FOV: 45 degrees:
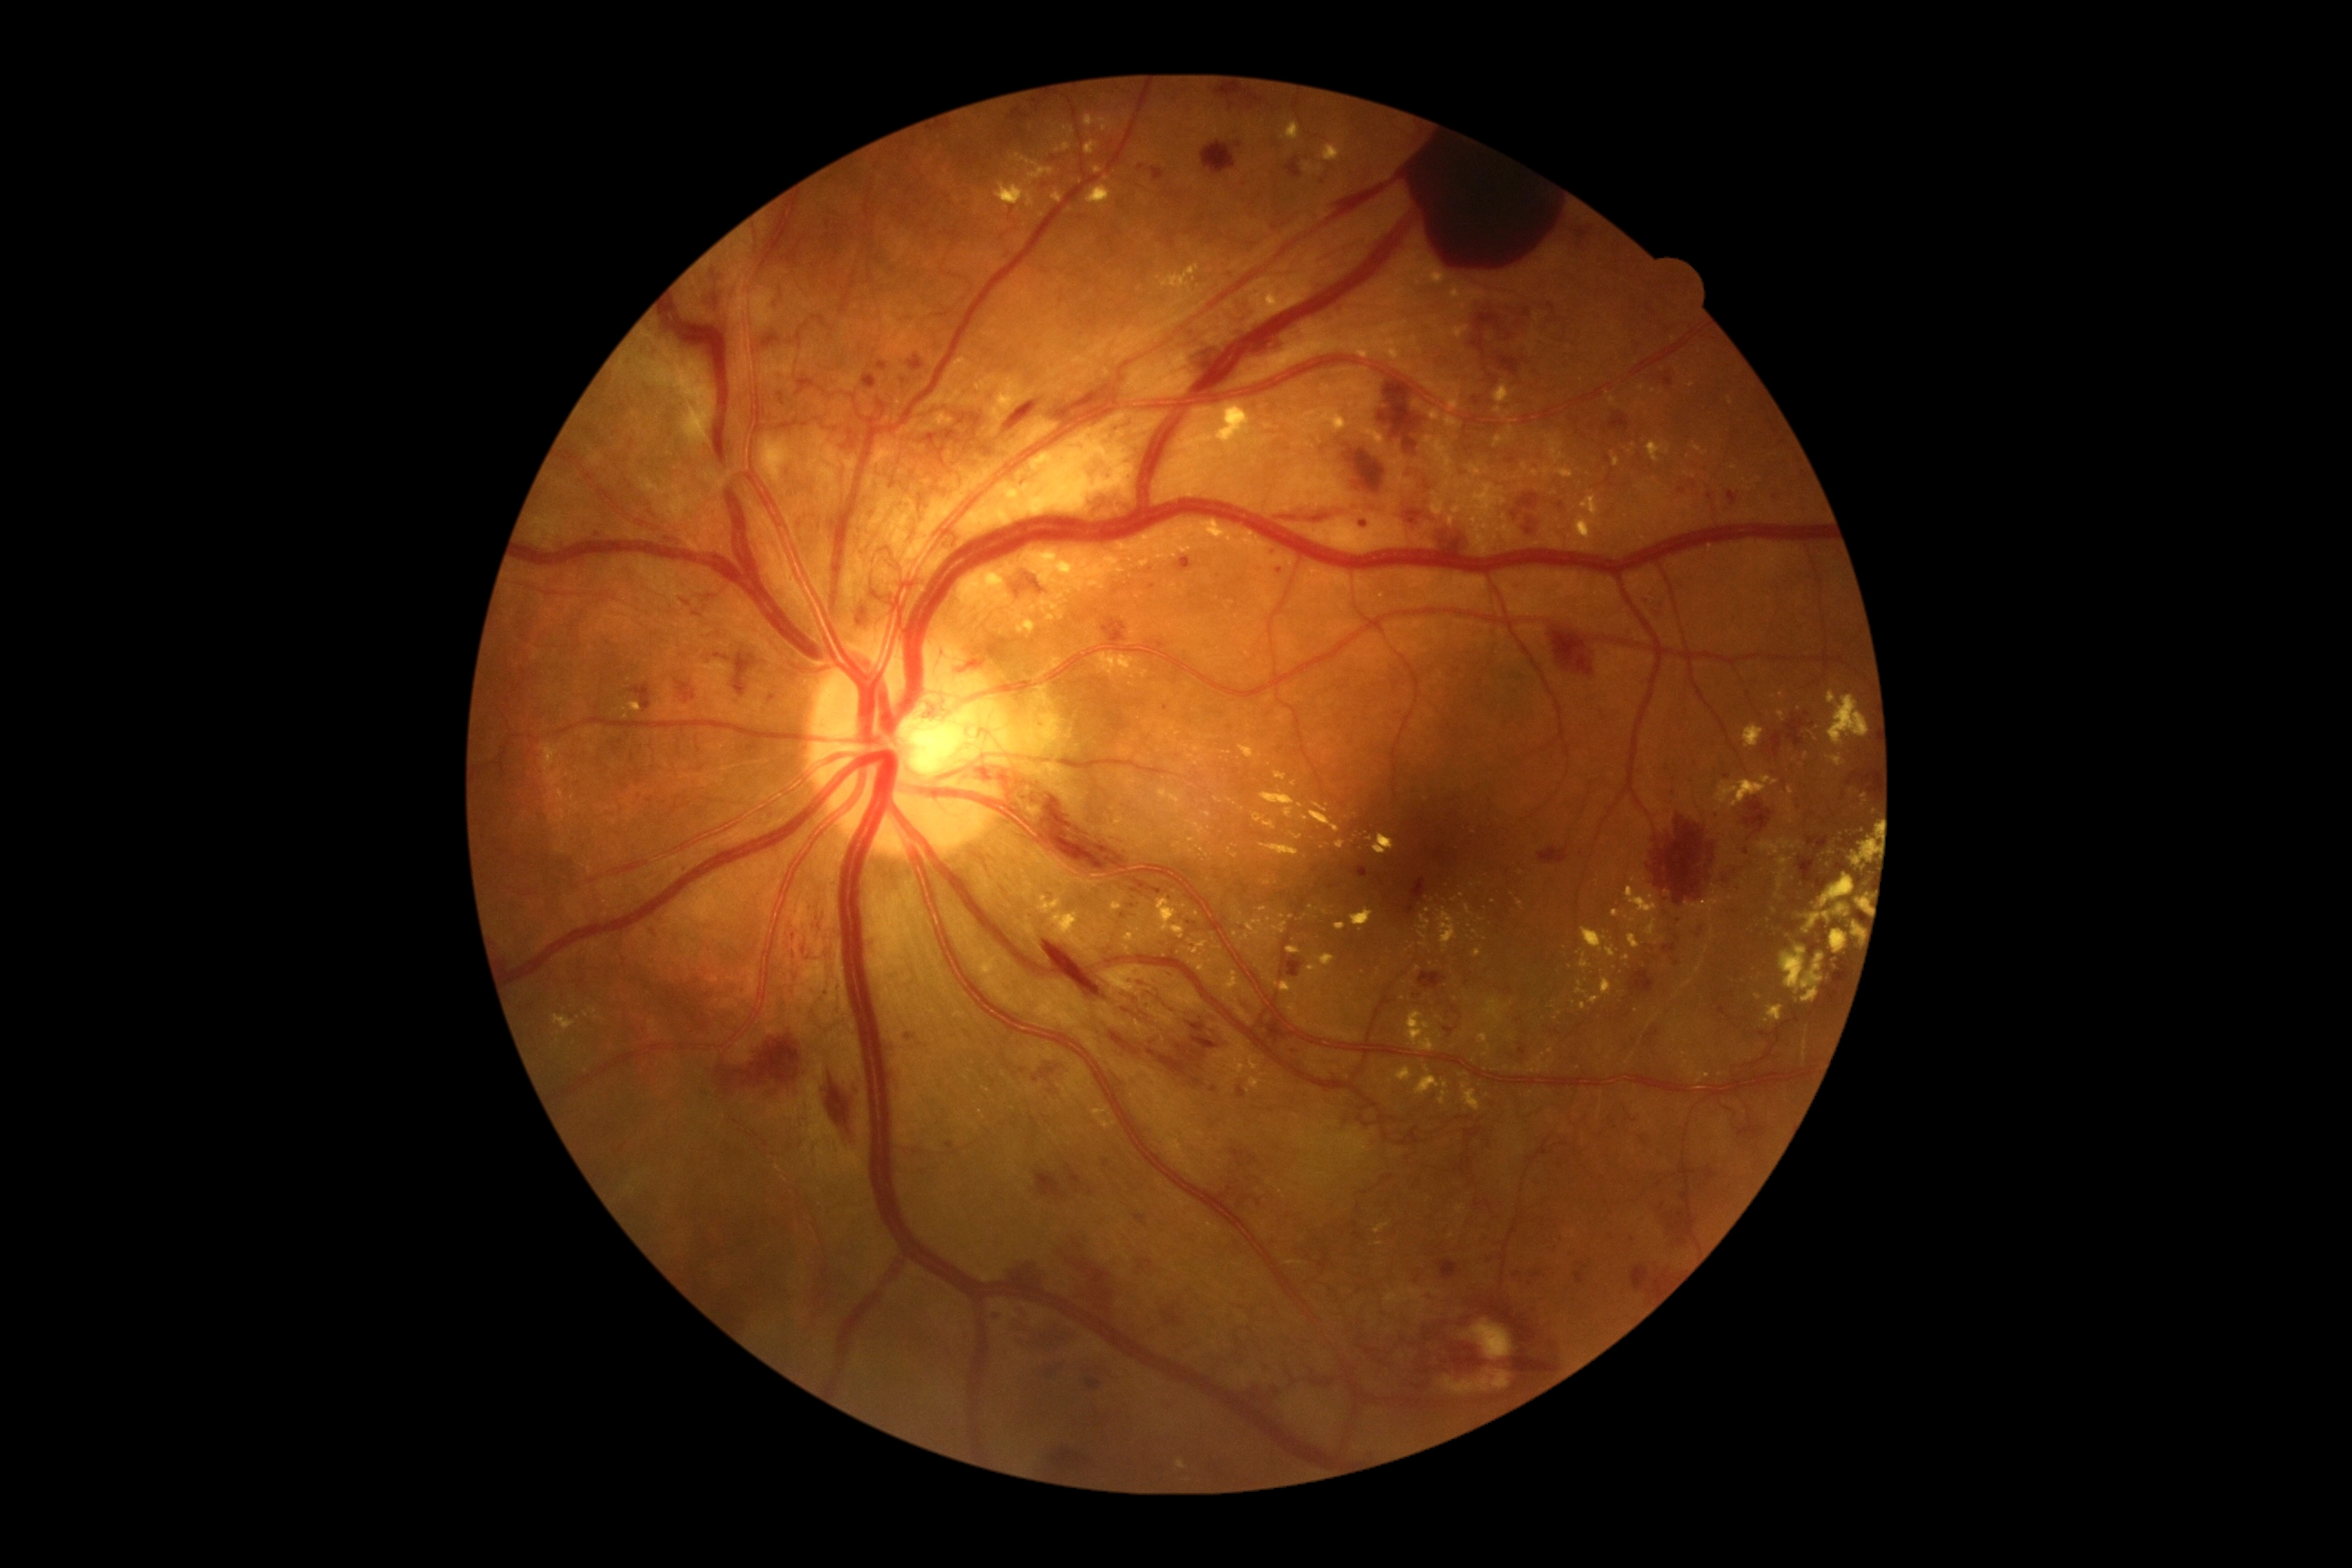

partial: true
dr_grade: 4
dr_grade_name: PDR
lesions:
  ex:
    - <box>1286,946,1300,954</box>
    - <box>1758,838,1803,858</box>
    - <box>1052,912,1088,950</box>
    - <box>1440,1092,1449,1106</box>
    - <box>1828,692,1870,749</box>
    - <box>1788,787,1794,796</box>
    - <box>1478,1034,1487,1043</box>
    - <box>1088,580,1104,591</box>
    - <box>1647,442,1671,464</box>
    - <box>1351,908,1375,926</box>
    - <box>1415,966,1420,974</box>
    - <box>1367,838,1375,841</box>
    - <box>1444,416,1464,429</box>
  ex_small:
    - point(1469, 926)
    - point(1189, 850)
    - point(1269, 920)
    - point(1249, 741)
    - point(1174, 827)
  he:
    - <box>1803,812,1827,828</box>
    - <box>1663,945,1678,954</box>
    - <box>1162,703,1171,710</box>
    - <box>1211,1086,1219,1093</box>
    - <box>732,654,756,698</box>
    - <box>1175,558,1193,573</box>
    - <box>1231,1150,1259,1168</box>
    - <box>877,362,887,371</box>
    - <box>883,1041,897,1055</box>
    - <box>783,469,798,480</box>
    - <box>1772,712,1810,758</box>
    - <box>1264,1014,1298,1048</box>
    - <box>1631,970,1654,997</box>
    - <box>1378,371,1422,453</box>
  he_small:
    - point(1560, 1166)
    - point(1141, 169)
    - point(1727, 776)
    - point(1107, 1164)